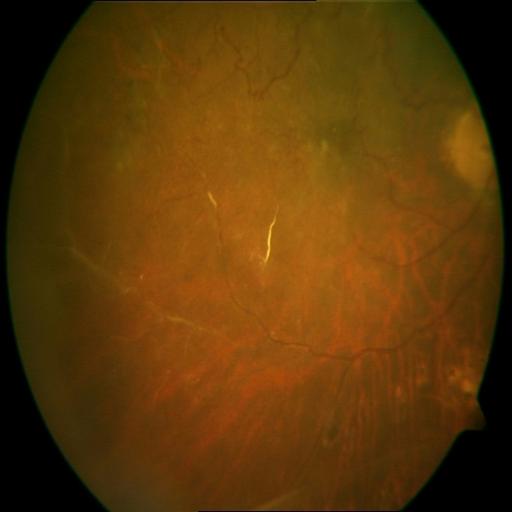

Diagnosis (2): collateral vessels; macular scar.